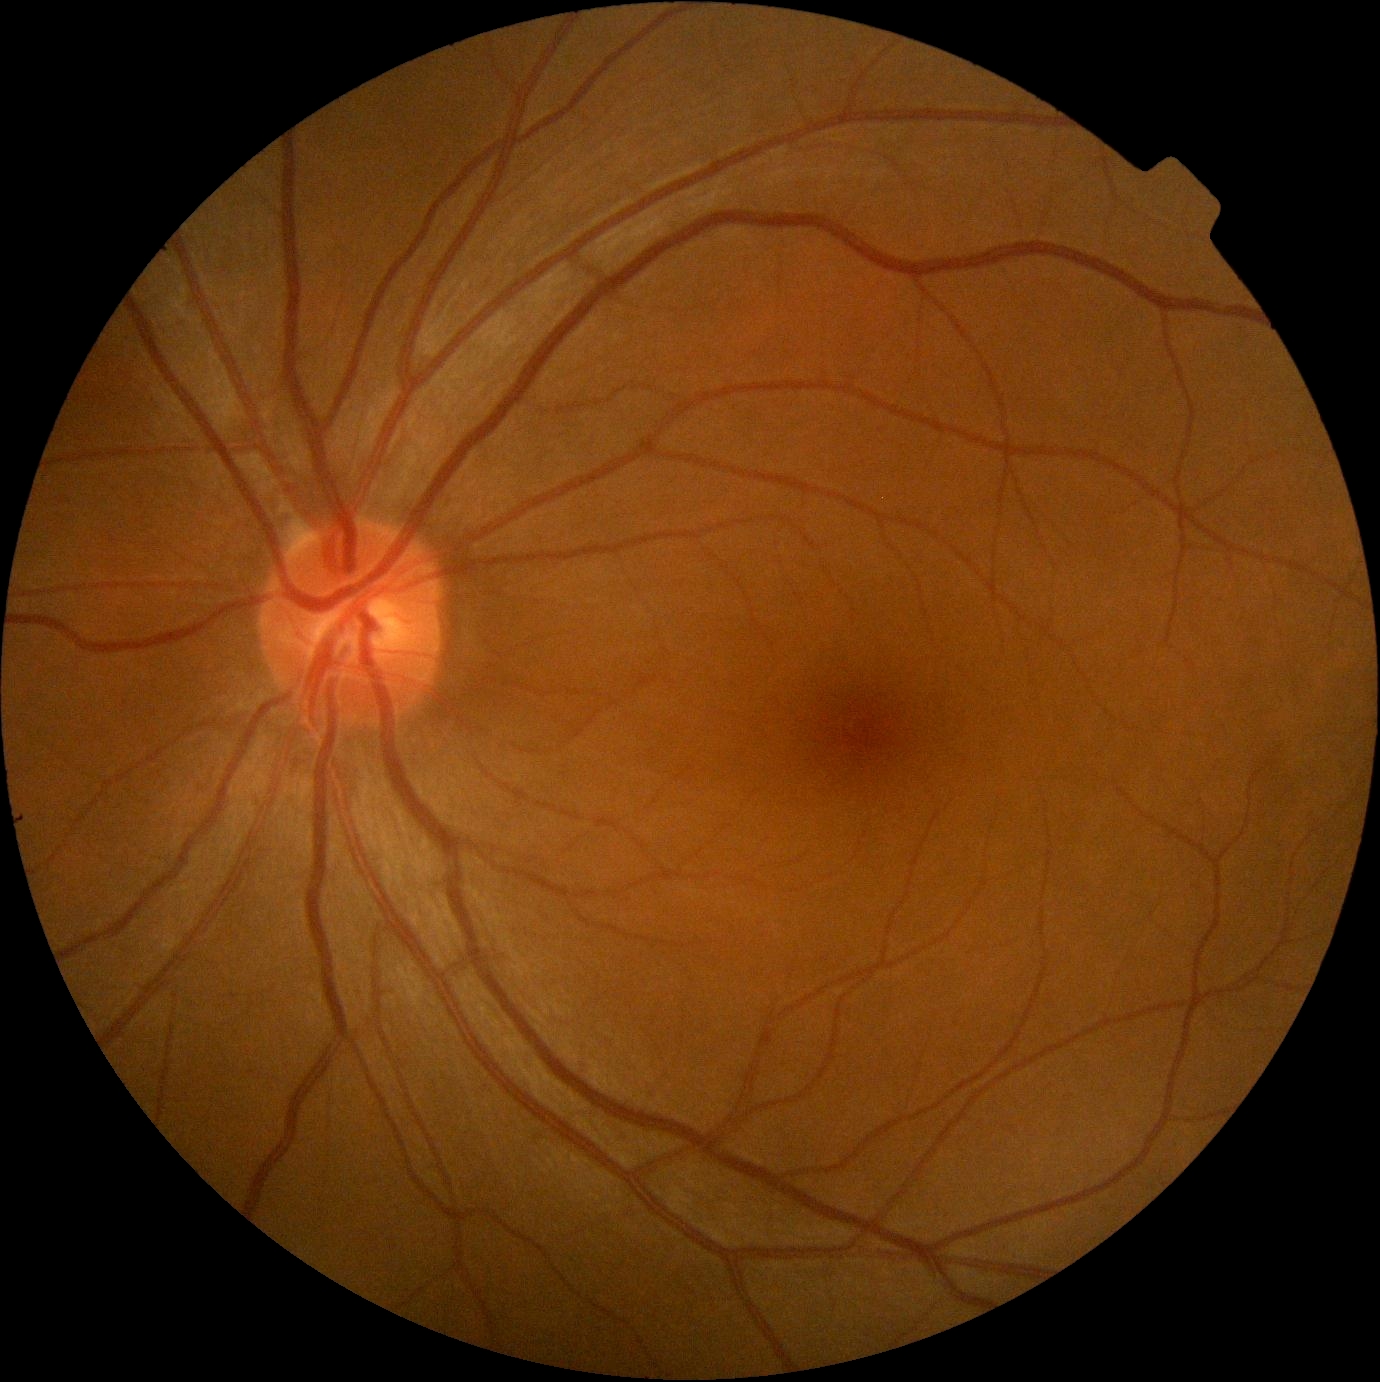 Annotations:
- retinopathy grade — no apparent retinopathy (0)